Wide-field contact fundus photograph of an infant — 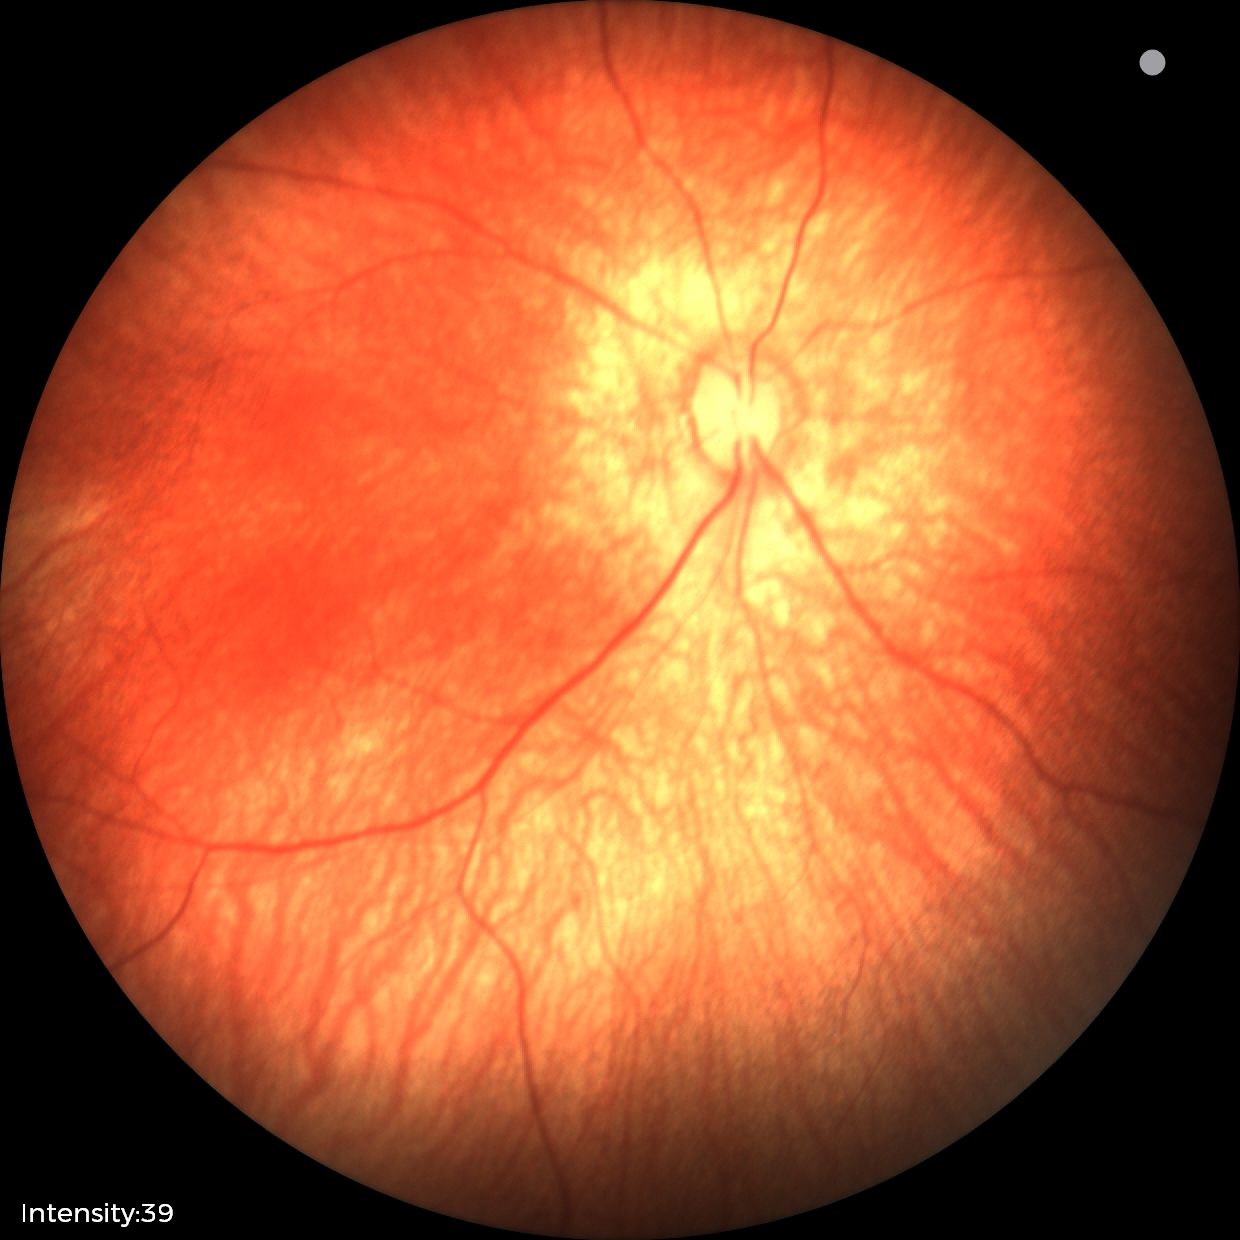
Screening: physiological appearance with no retinal pathology.